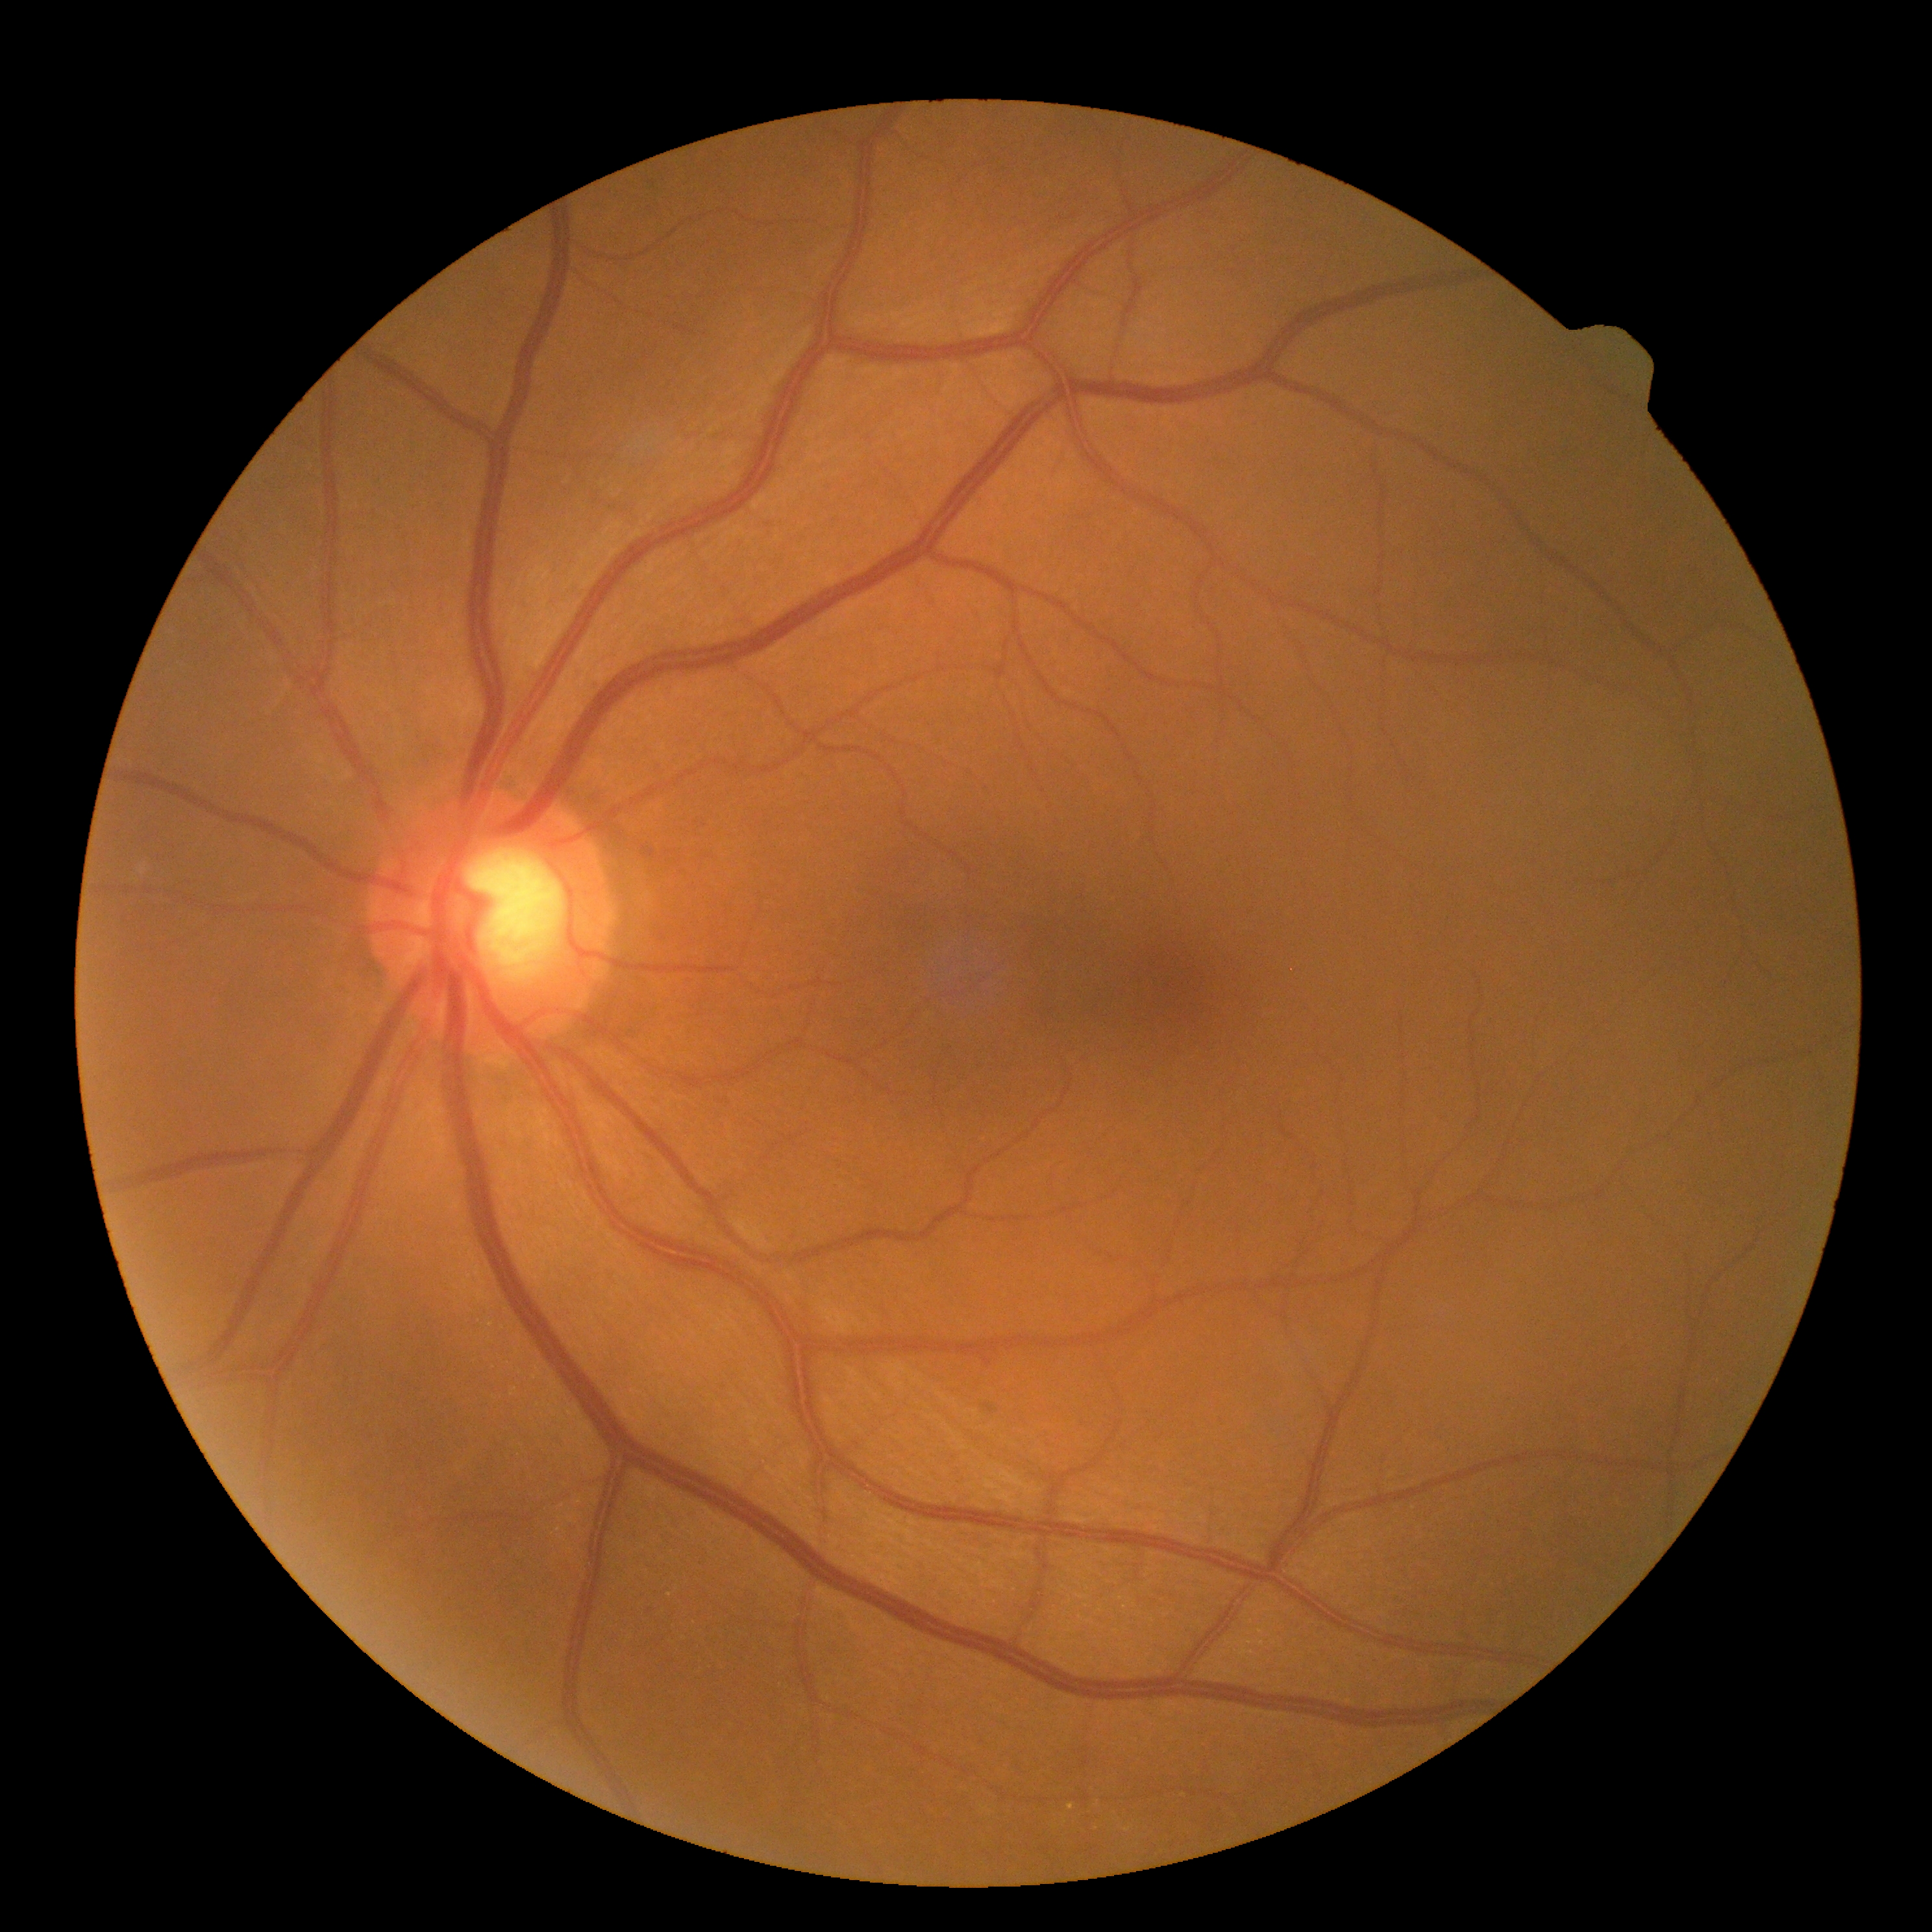

Diabetic retinopathy is 0/4.
No DR findings.